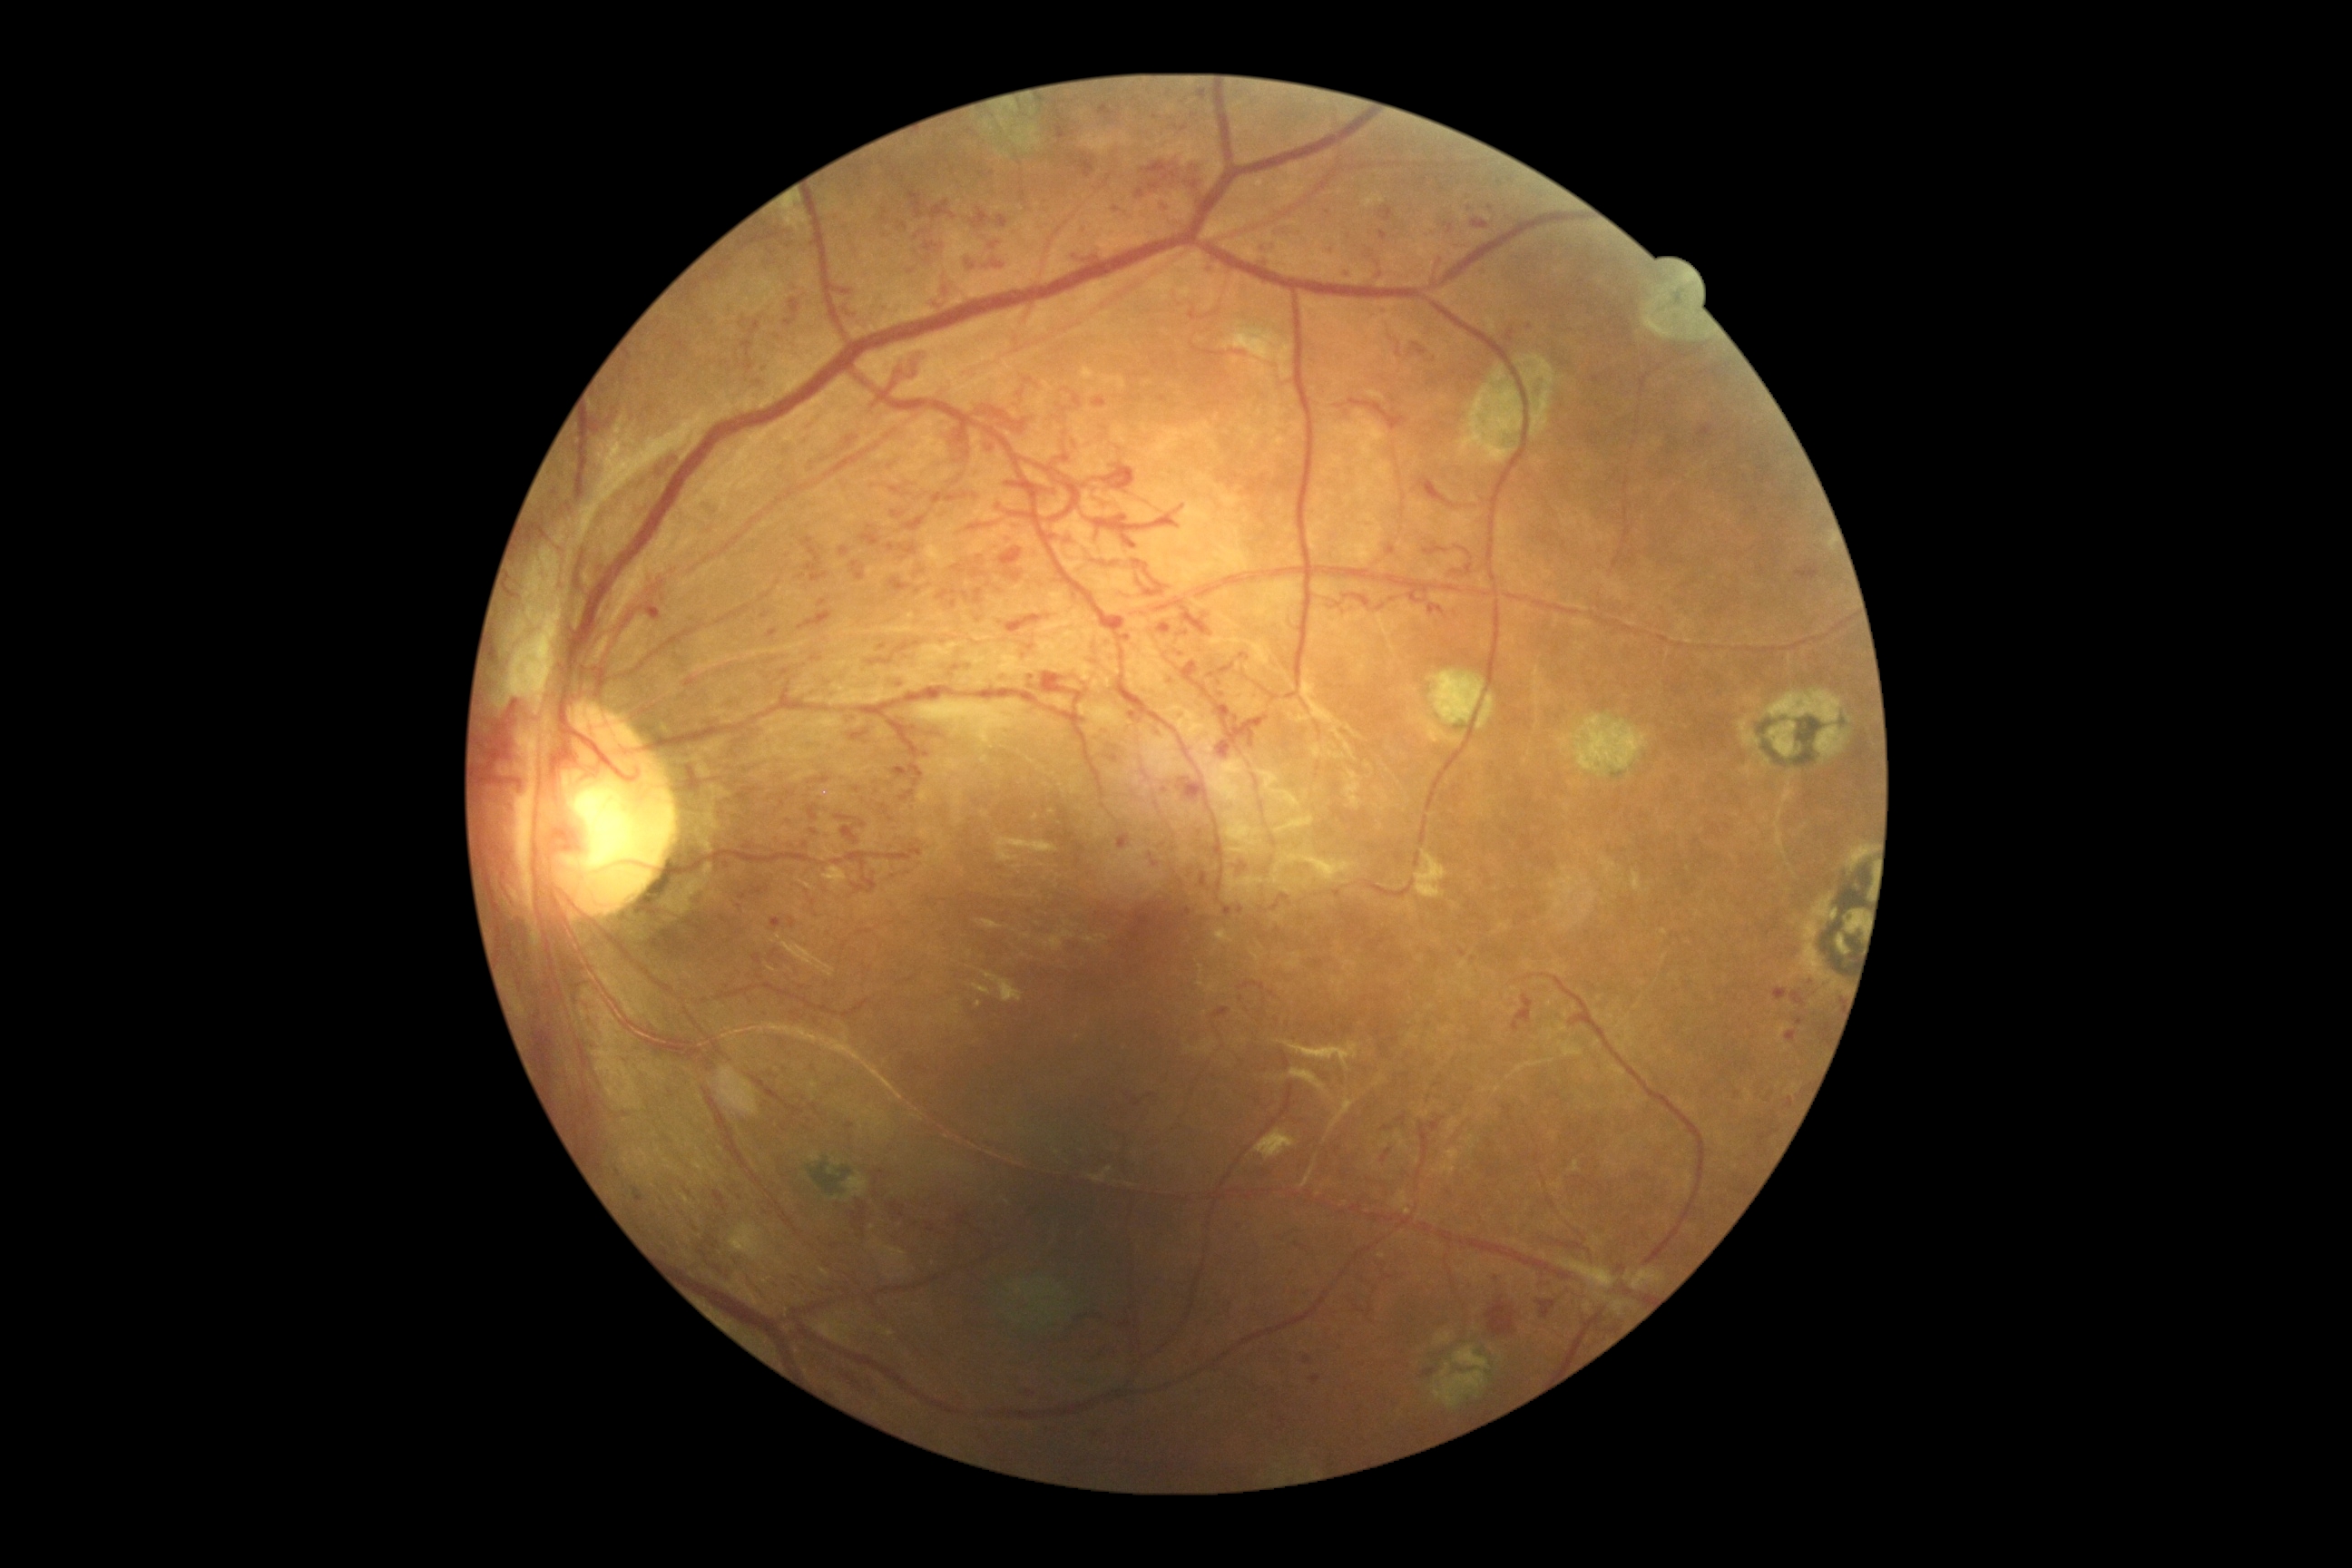 DR severity is 4 — neovascularization and/or vitreous/pre-retinal hemorrhage.